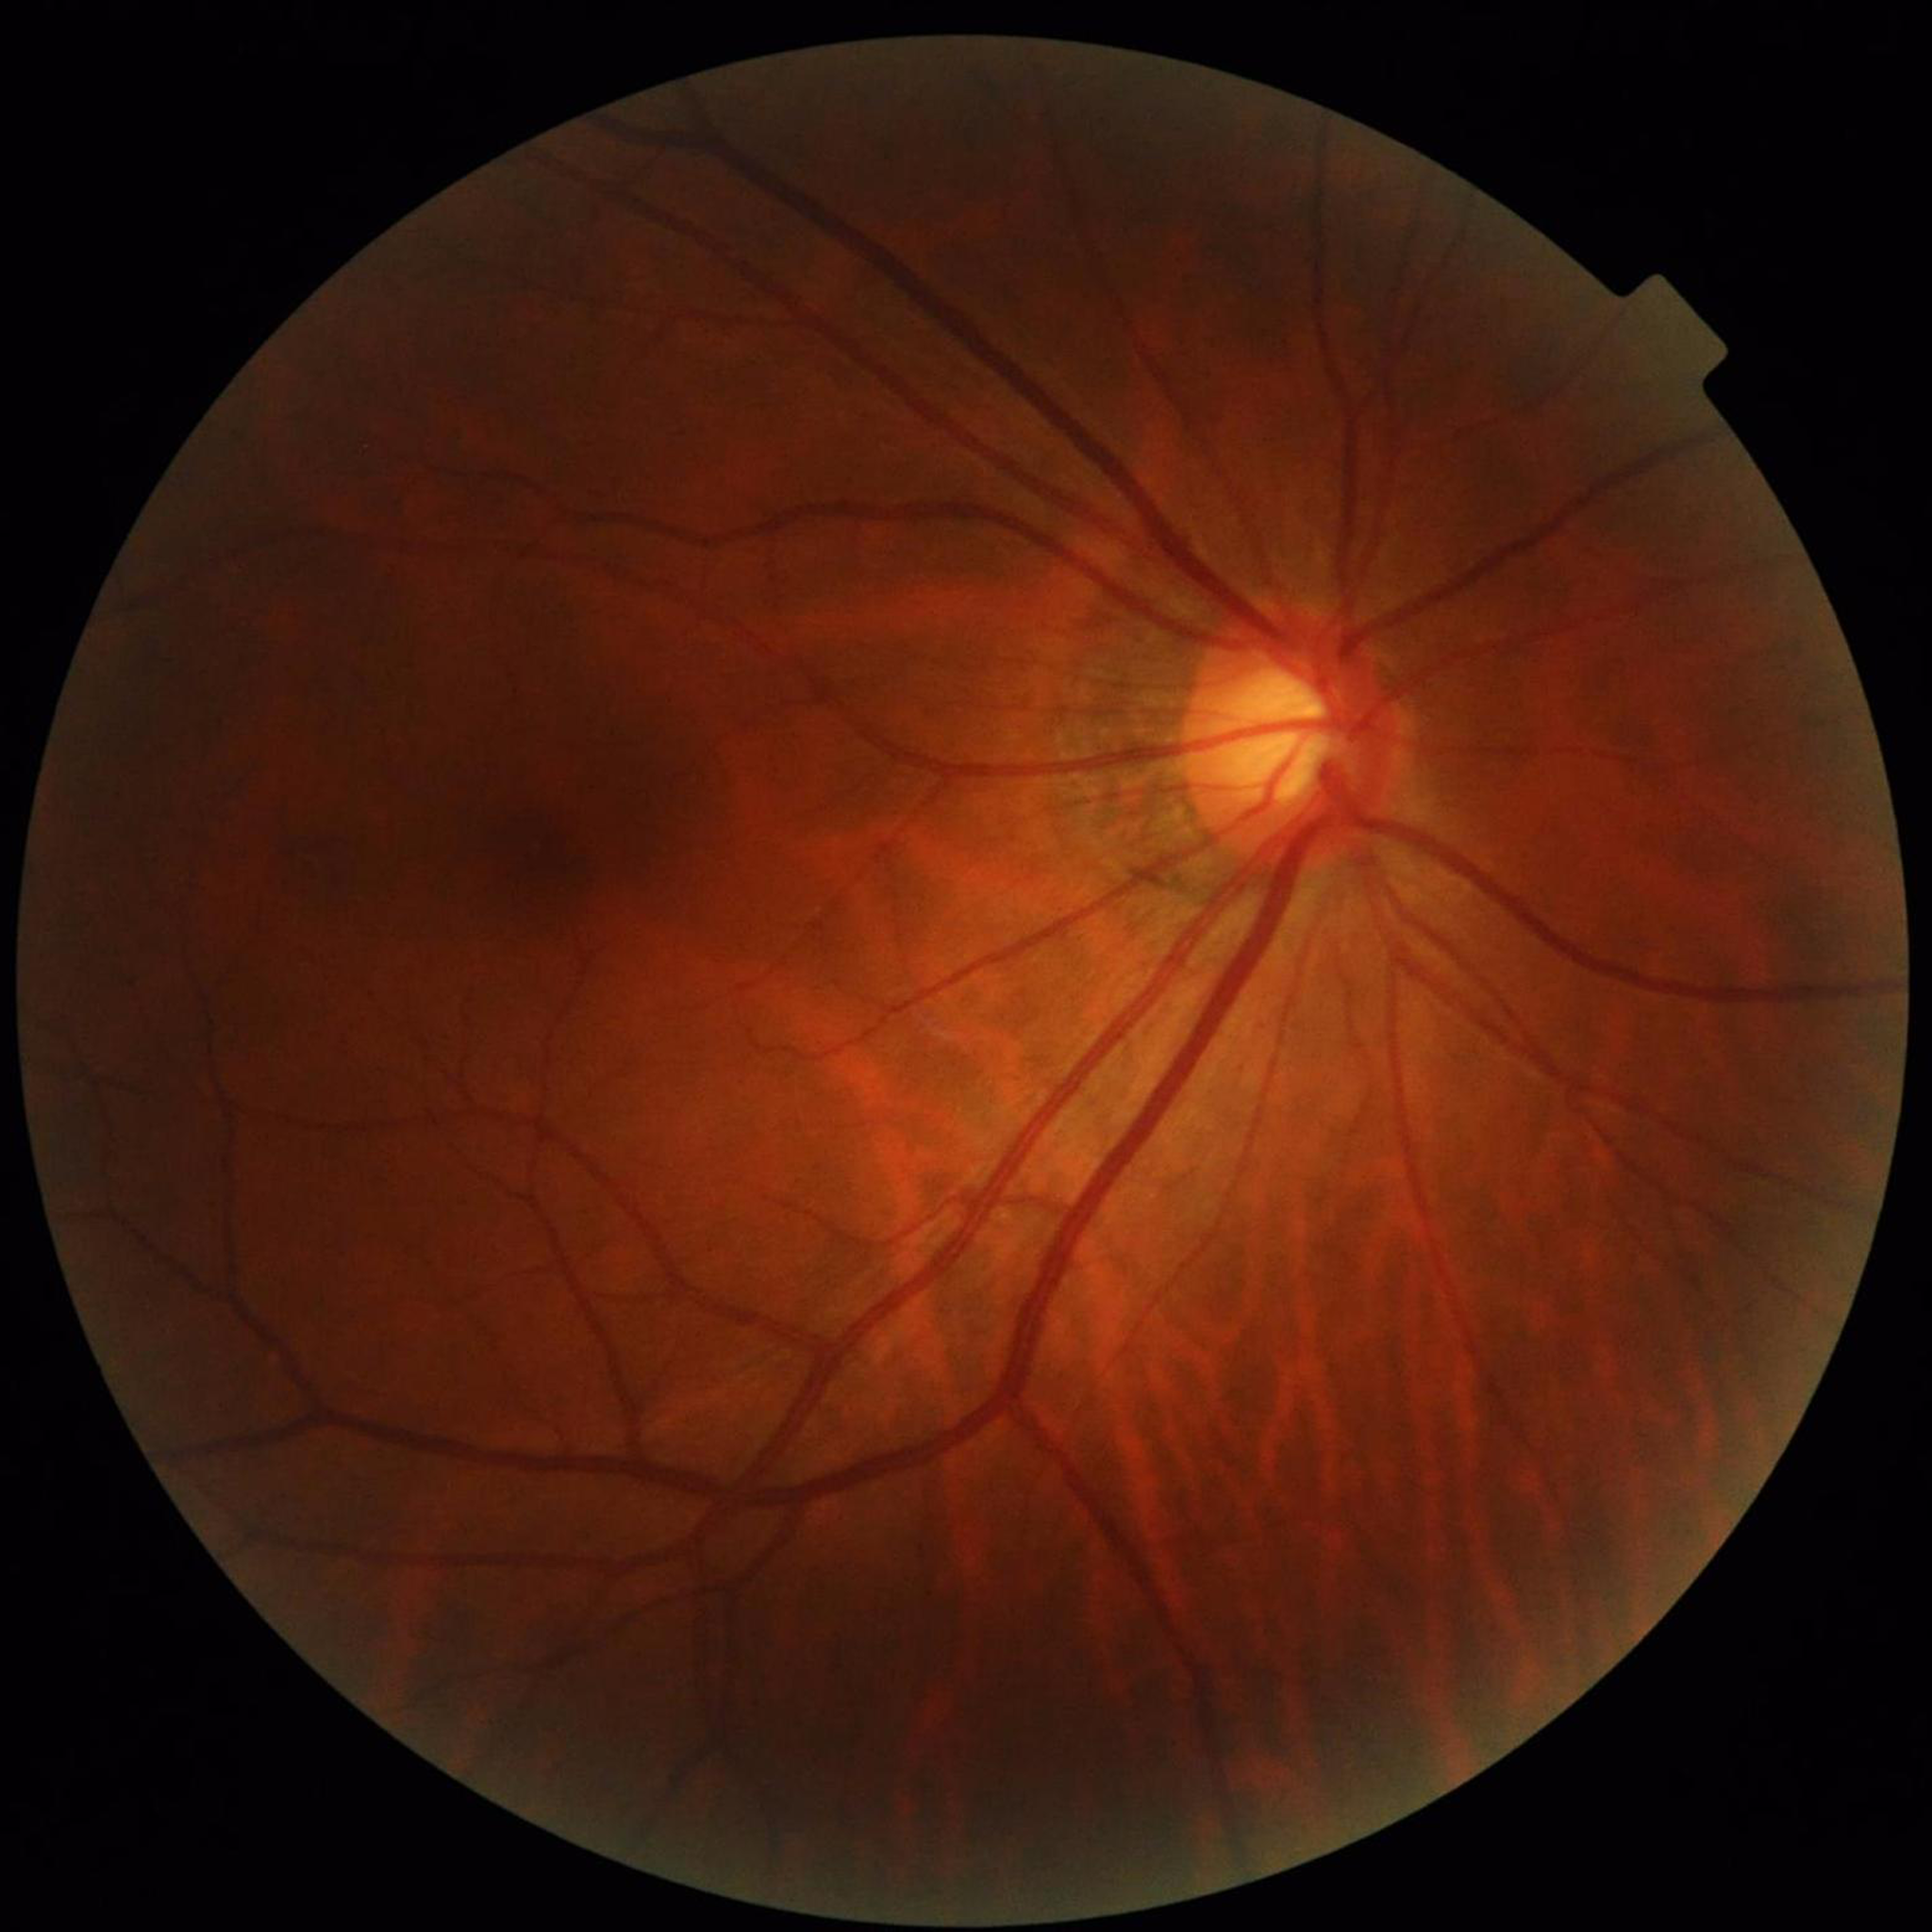 Retinal fundus photograph from a patient with glaucoma.